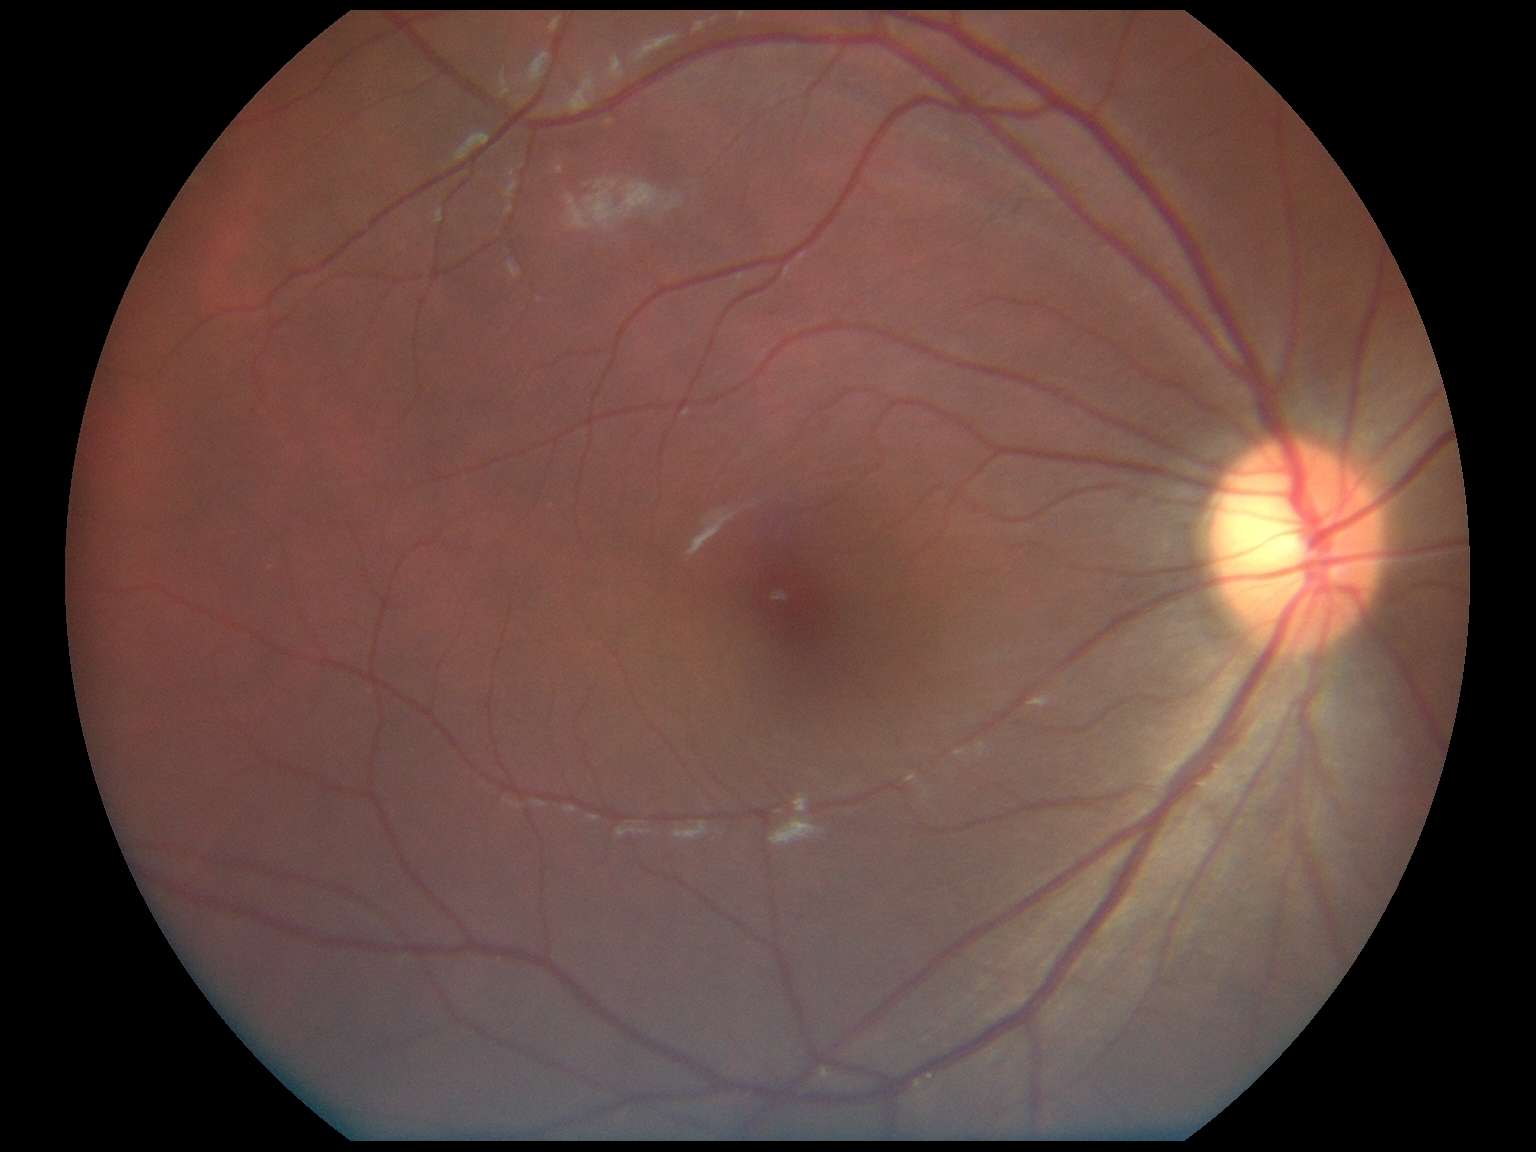

DR = no apparent retinopathy (grade 0) — no visible signs of diabetic retinopathy; DR impression = no signs of DR.